2212x1659px; 45° FOV: 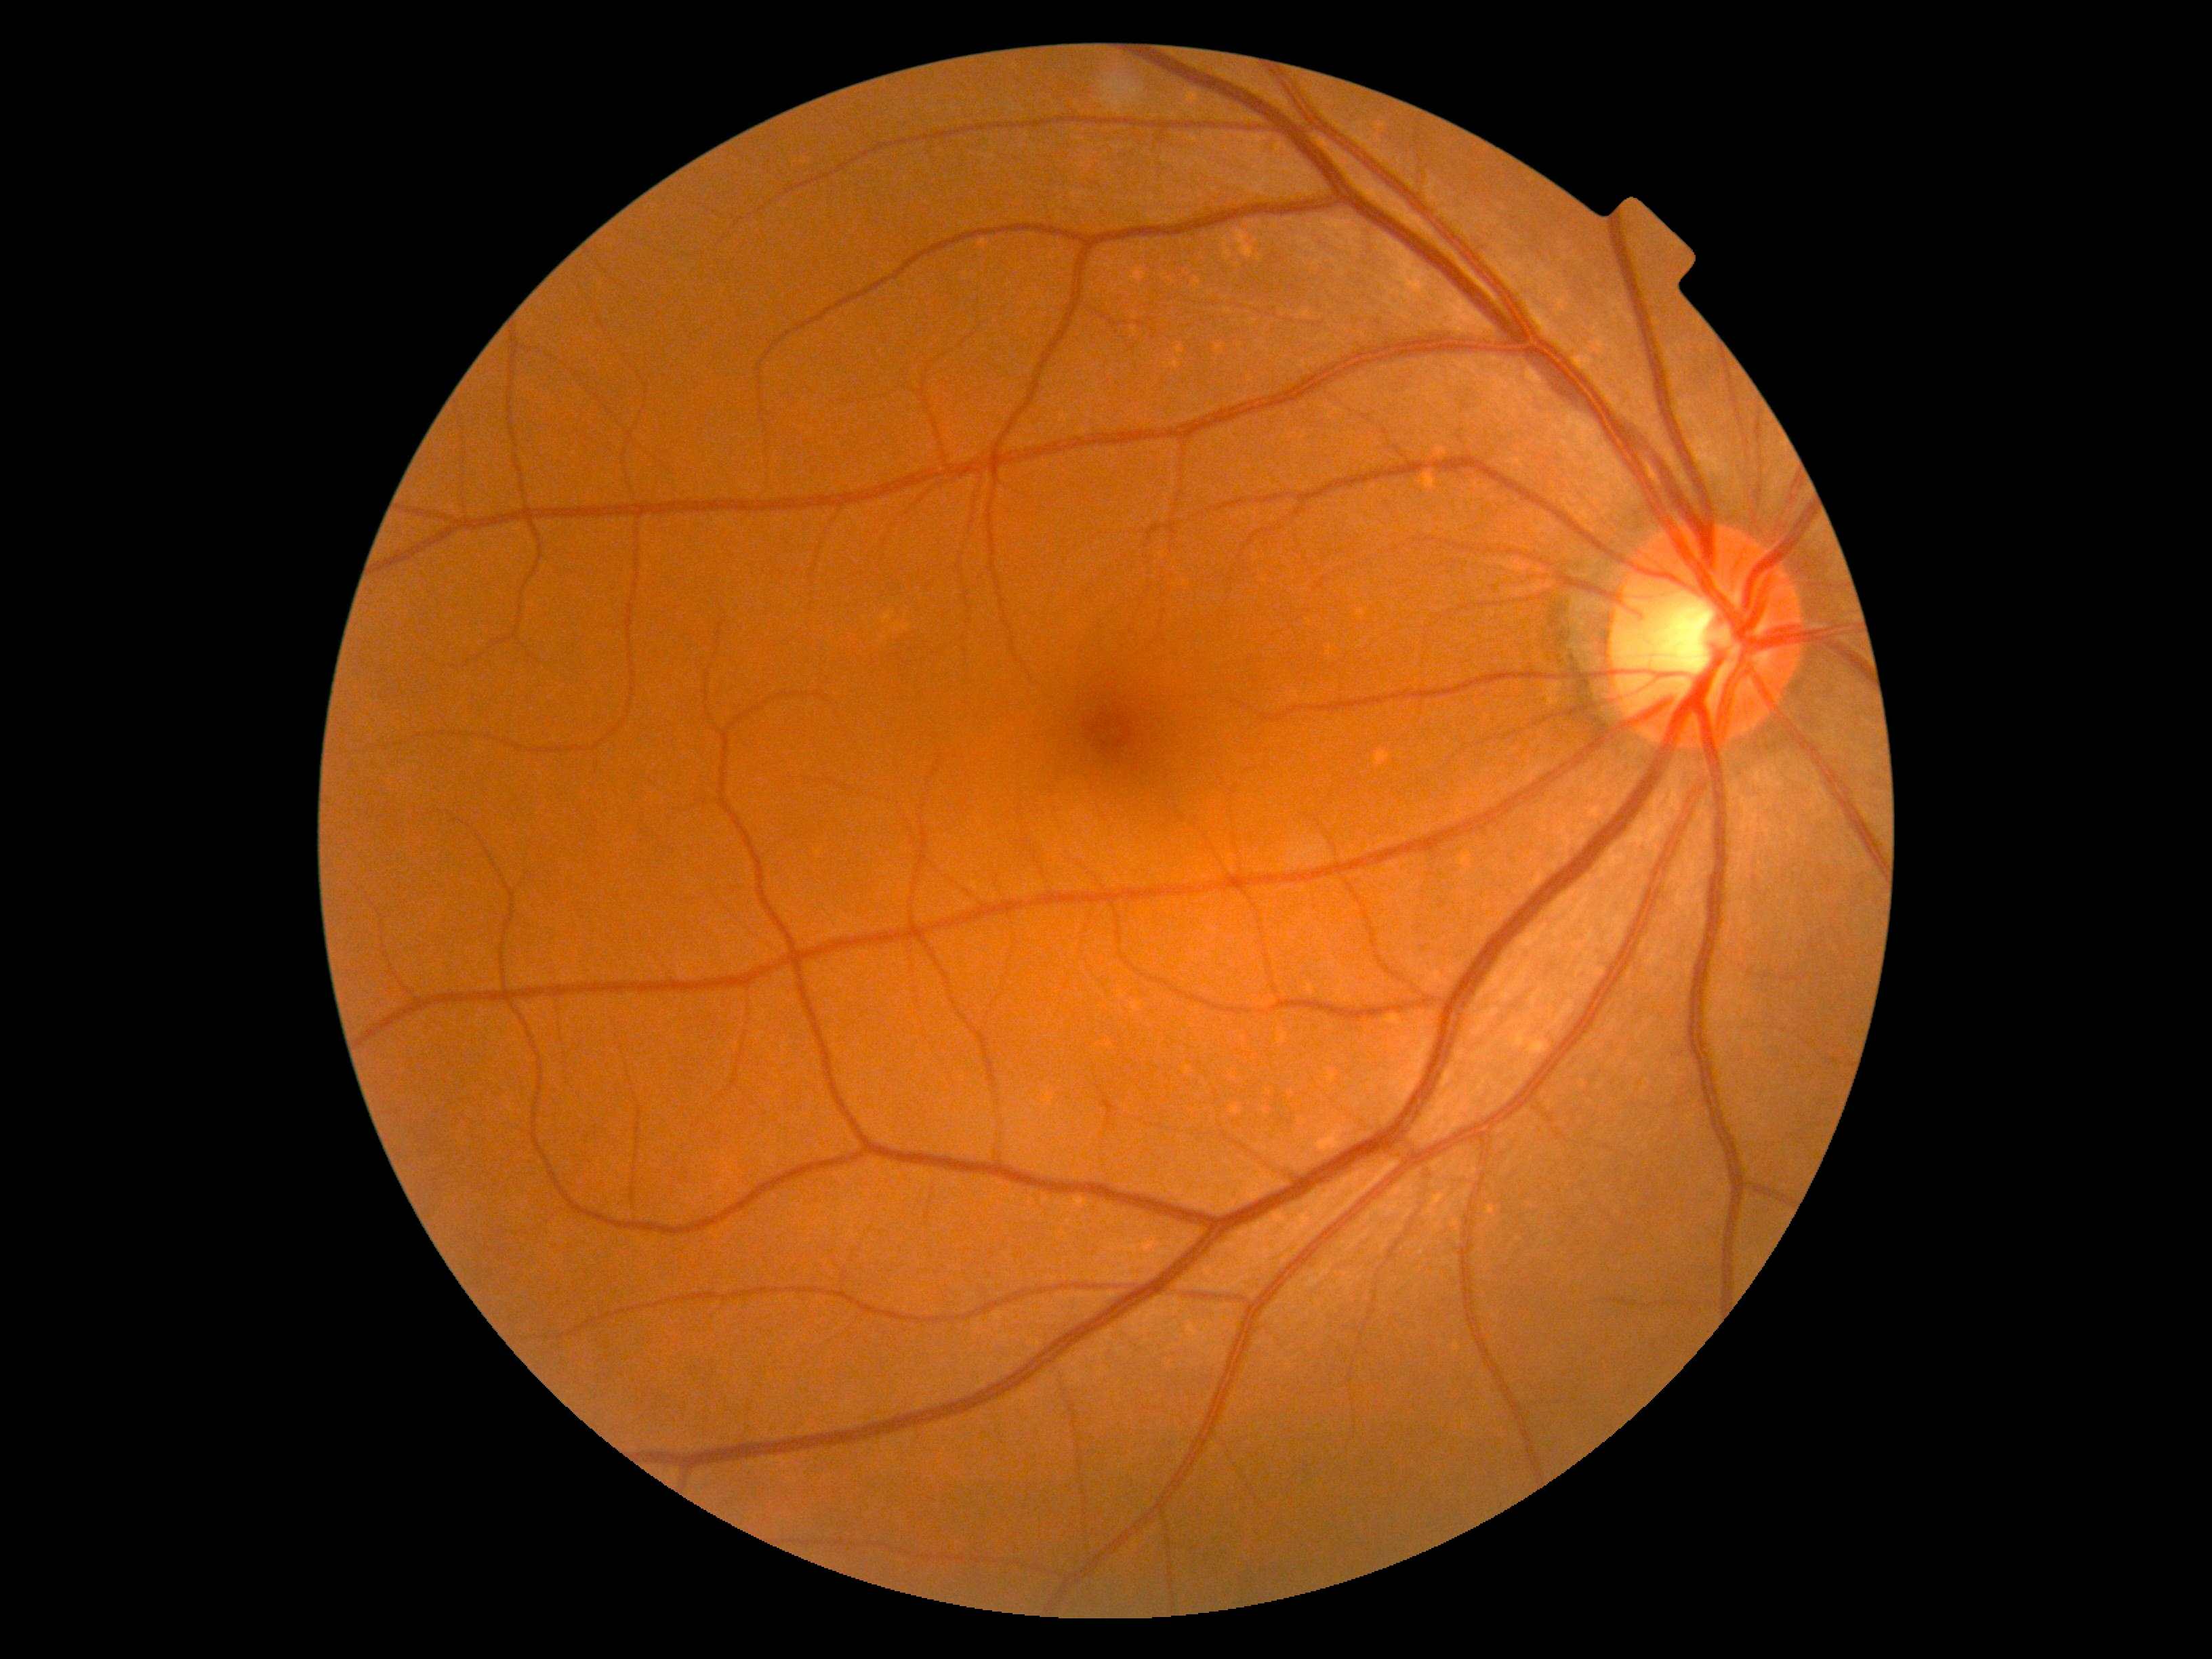
Diabetic retinopathy (DR): grade 0 (no apparent retinopathy).